Color fundus photograph · 2048 x 1536 pixels · 45-degree field of view — 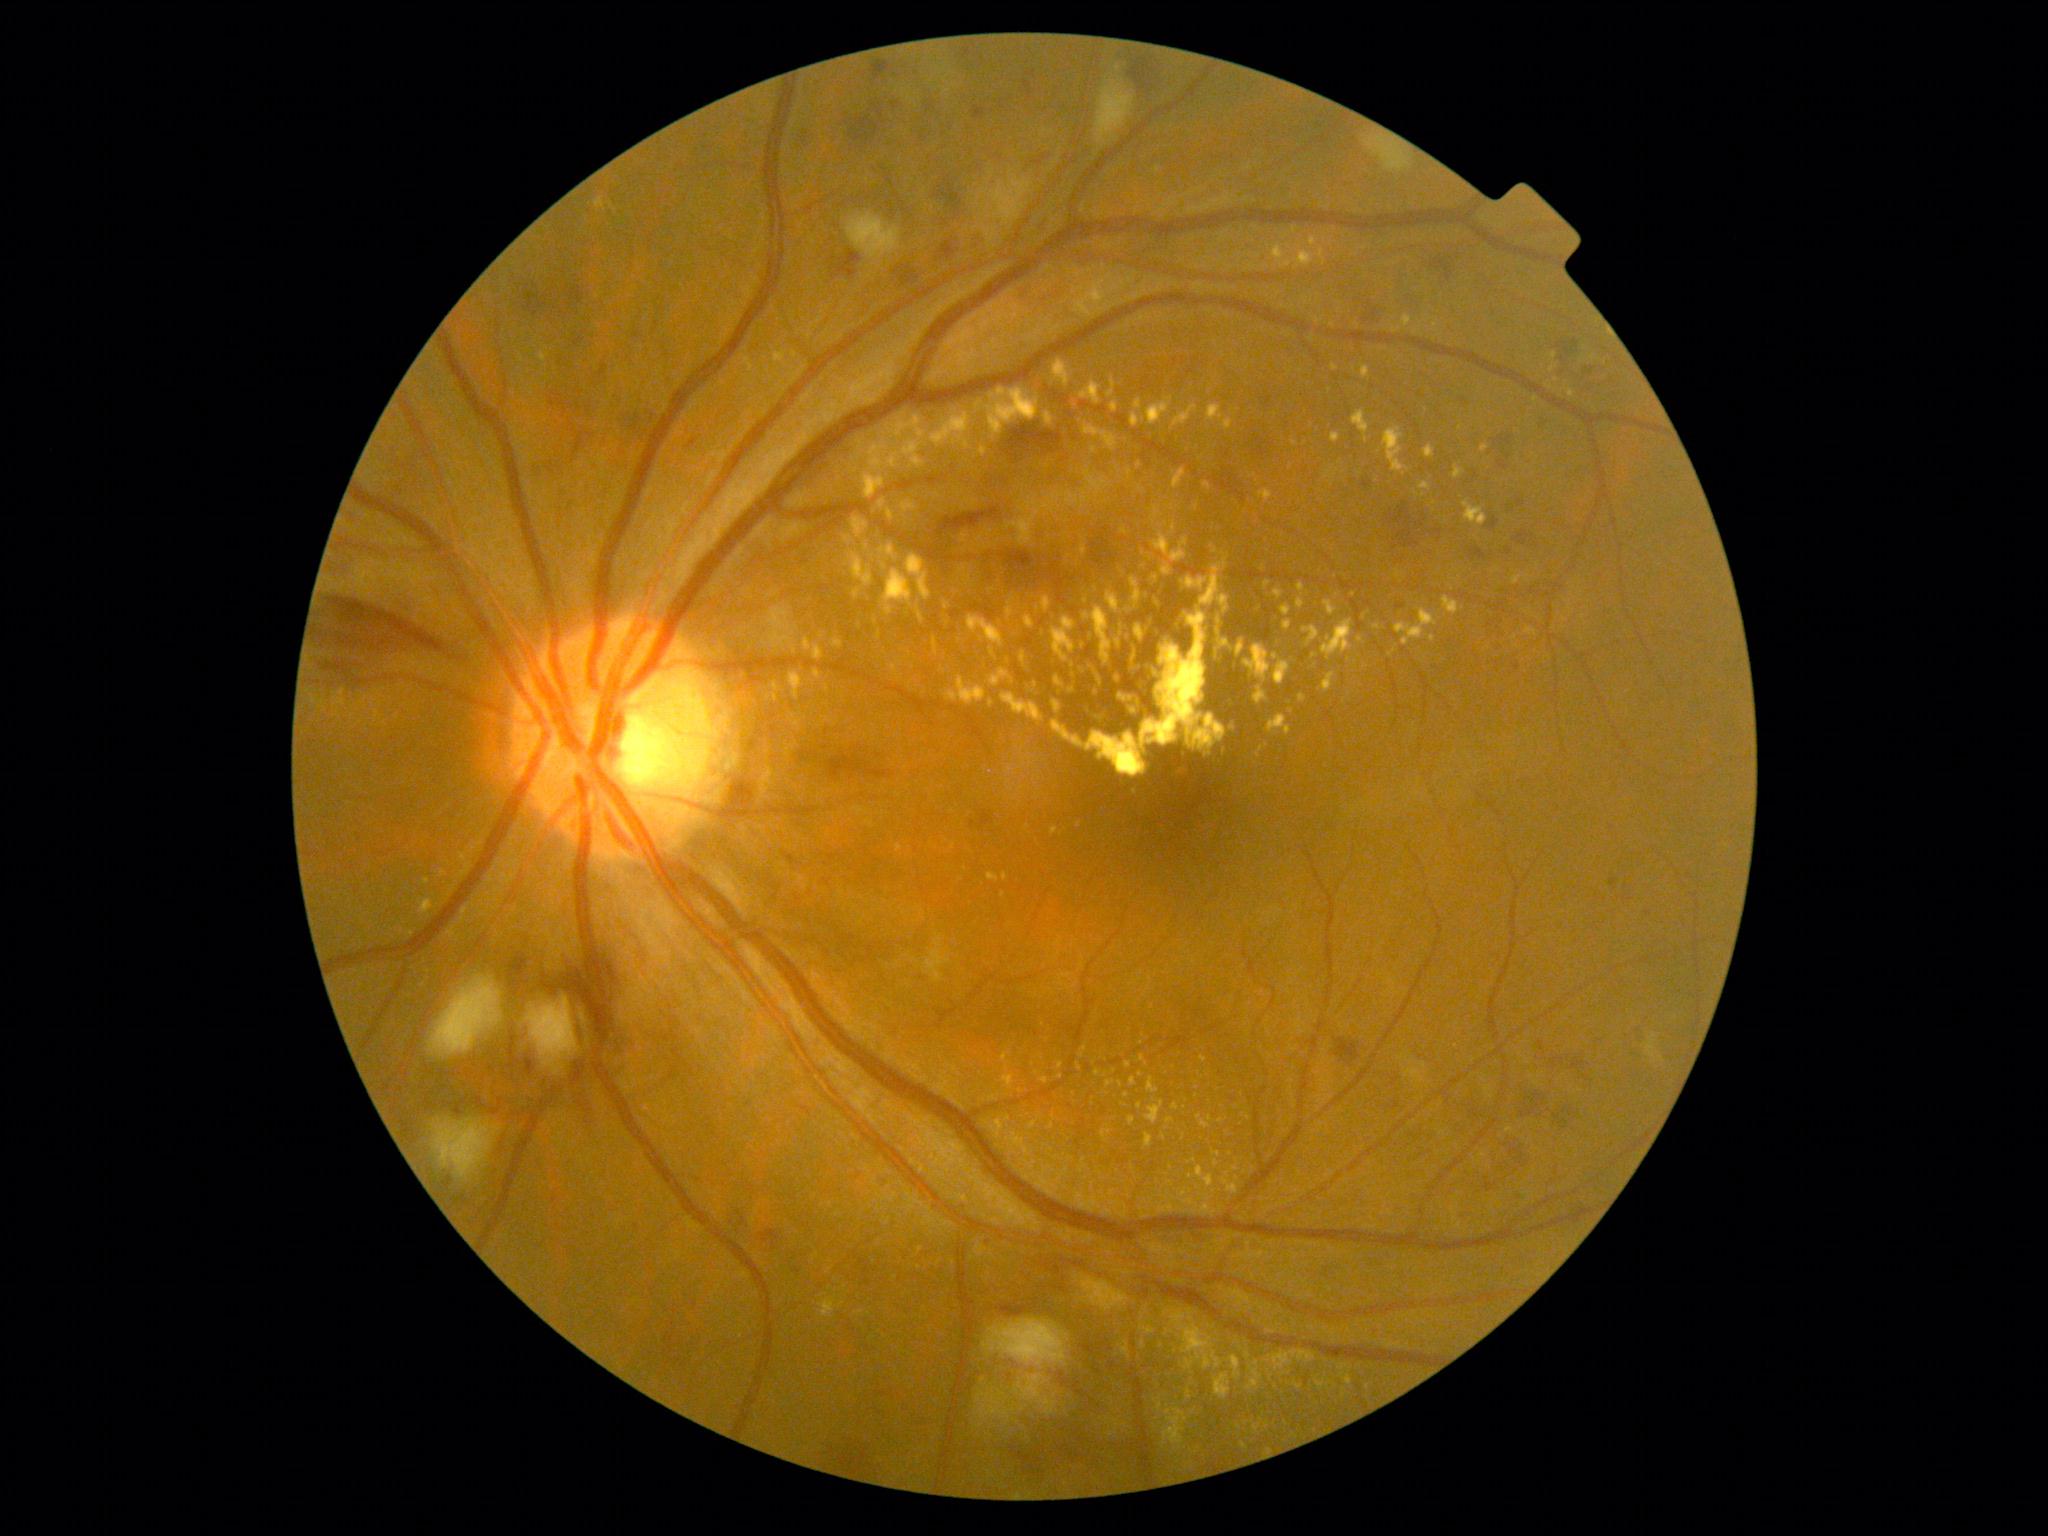 Annotations:
- diabetic retinopathy grade — 3